1932 by 1932 pixels — 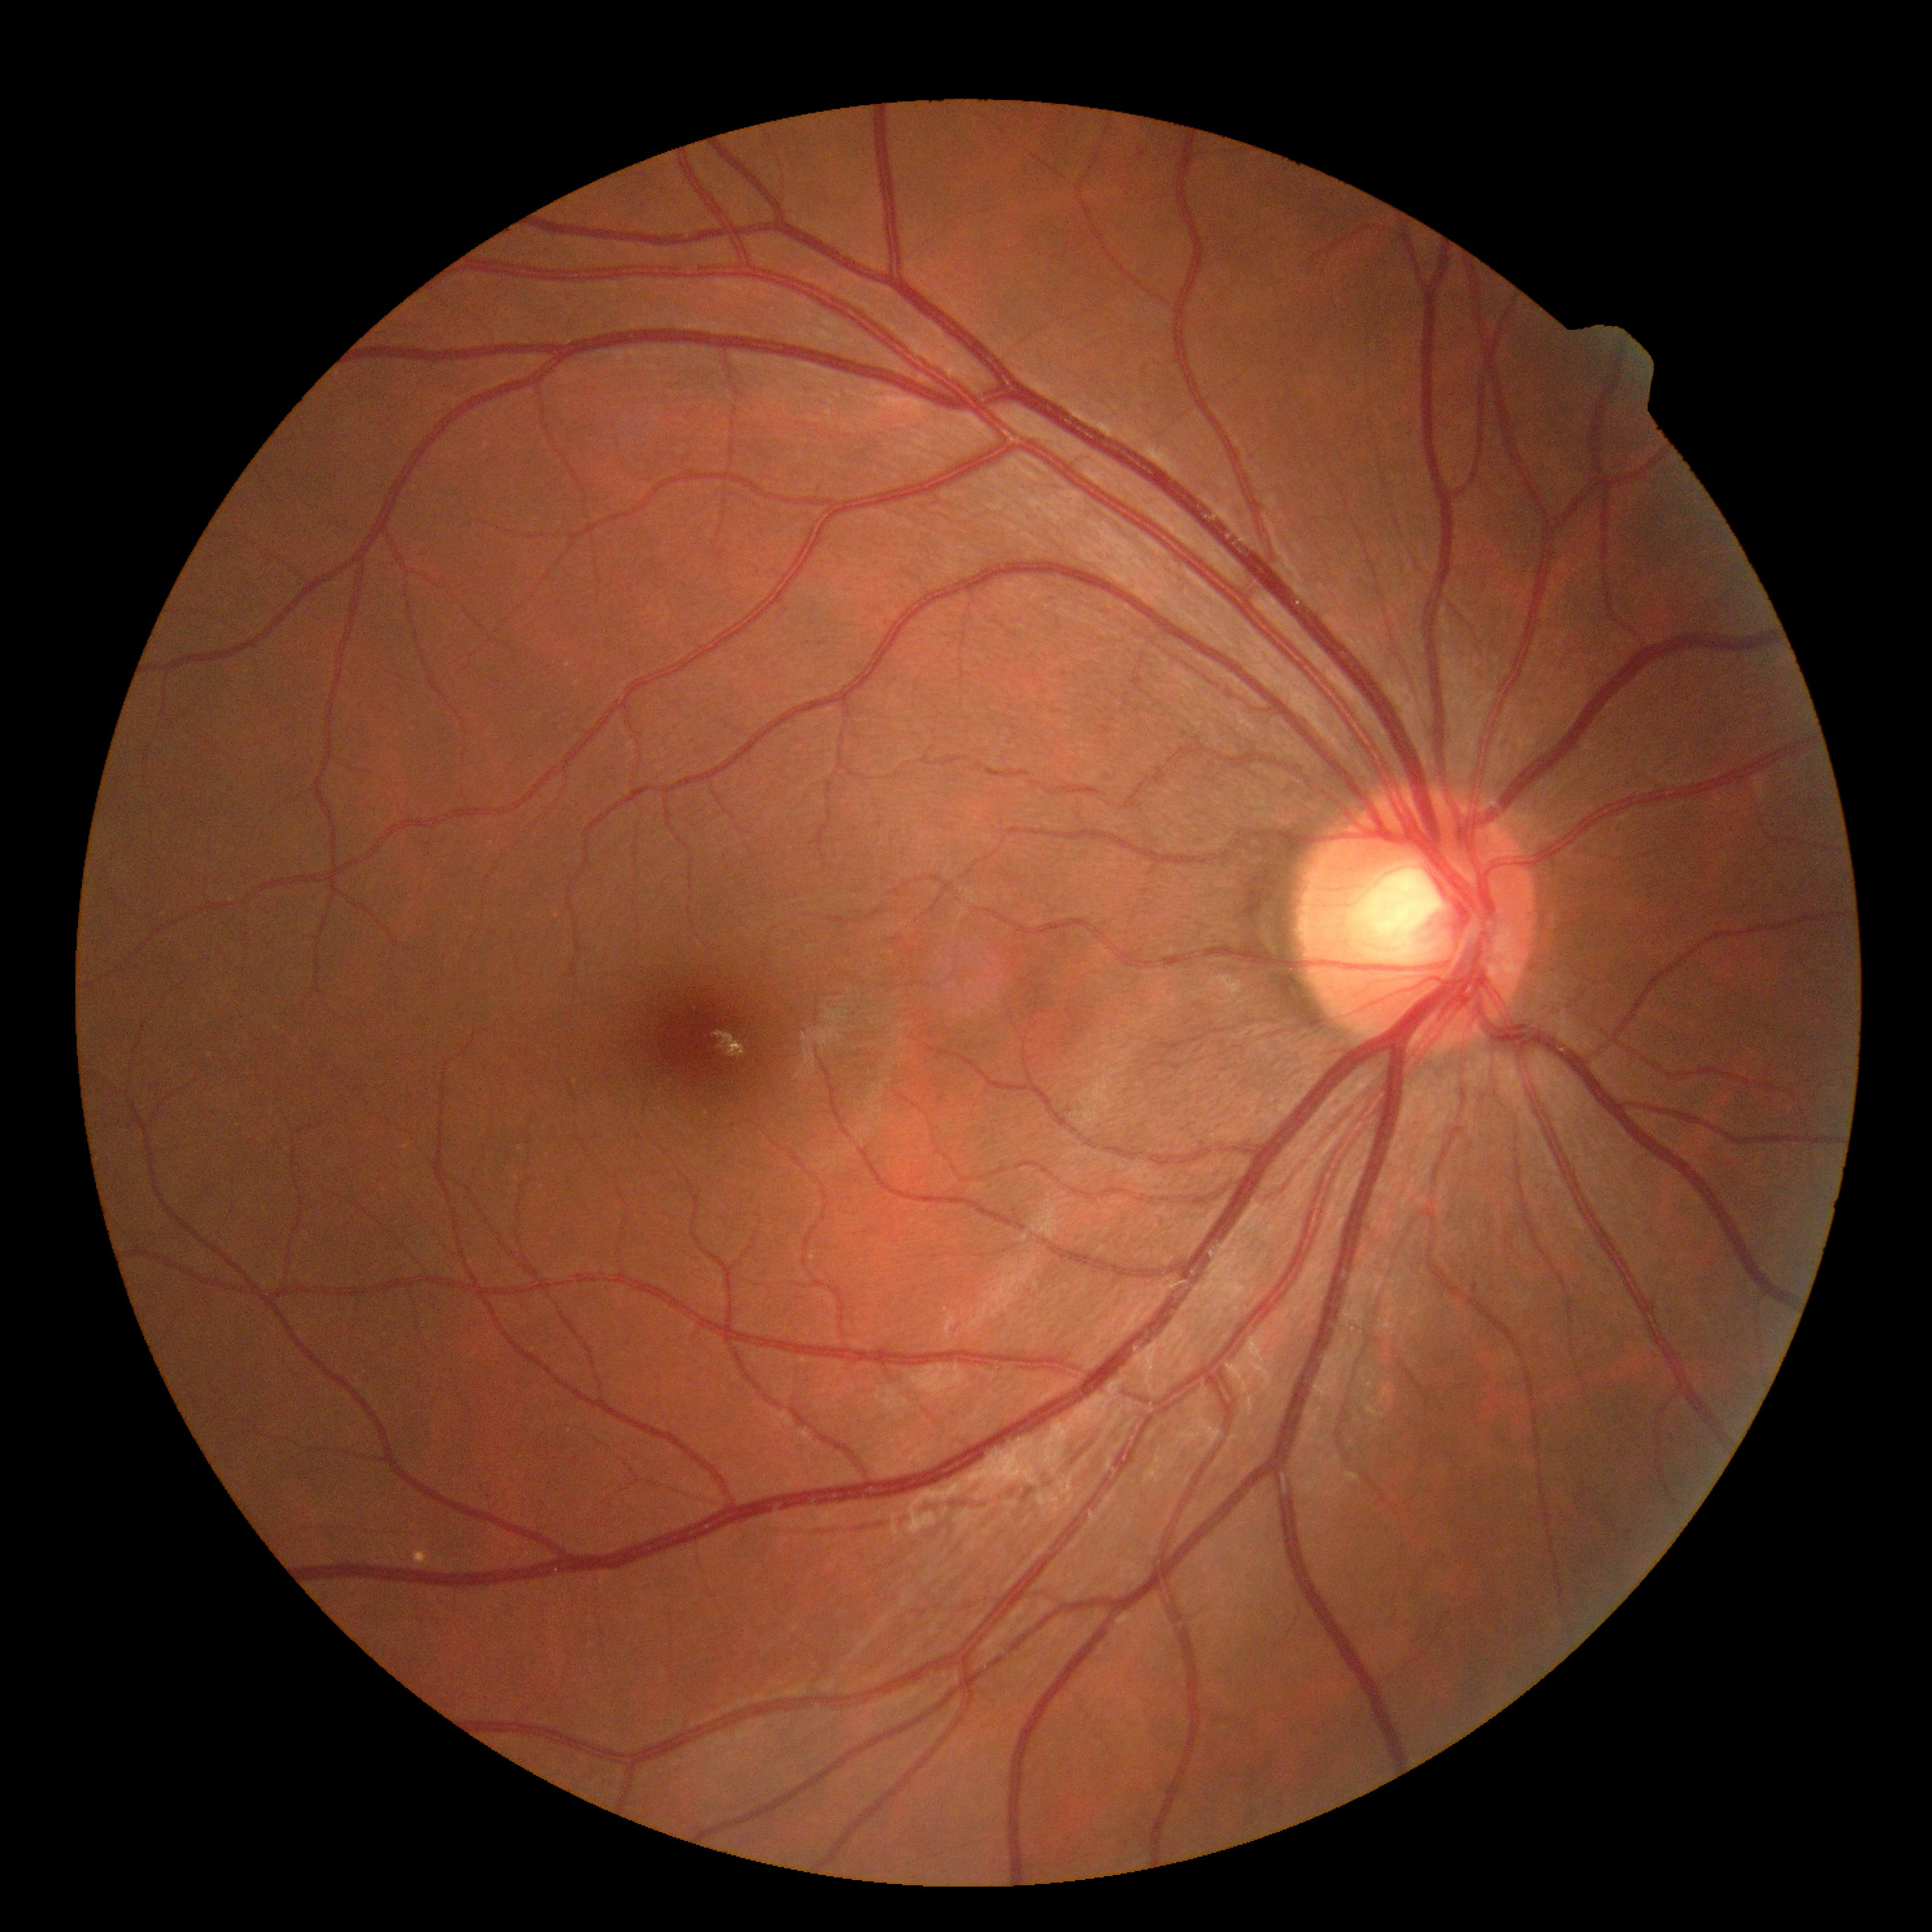
DR impression: no apparent DR, retinopathy grade: 0 (no apparent retinopathy).